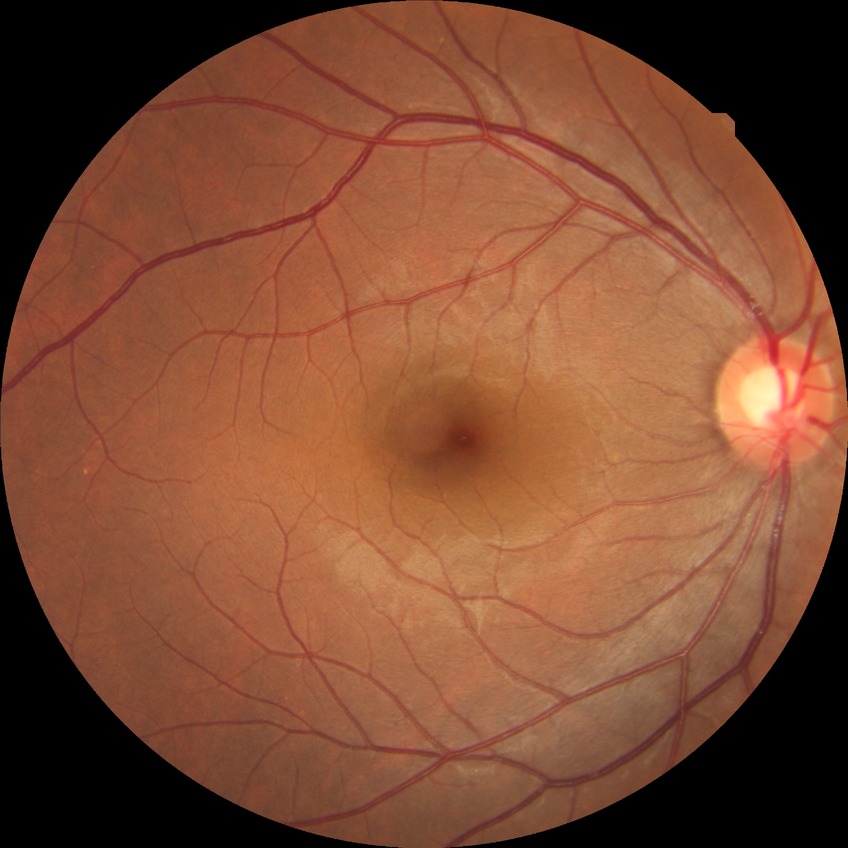

{
  "davis_grade": "no diabetic retinopathy (NDR)"
}